Infant wide-field retinal image:
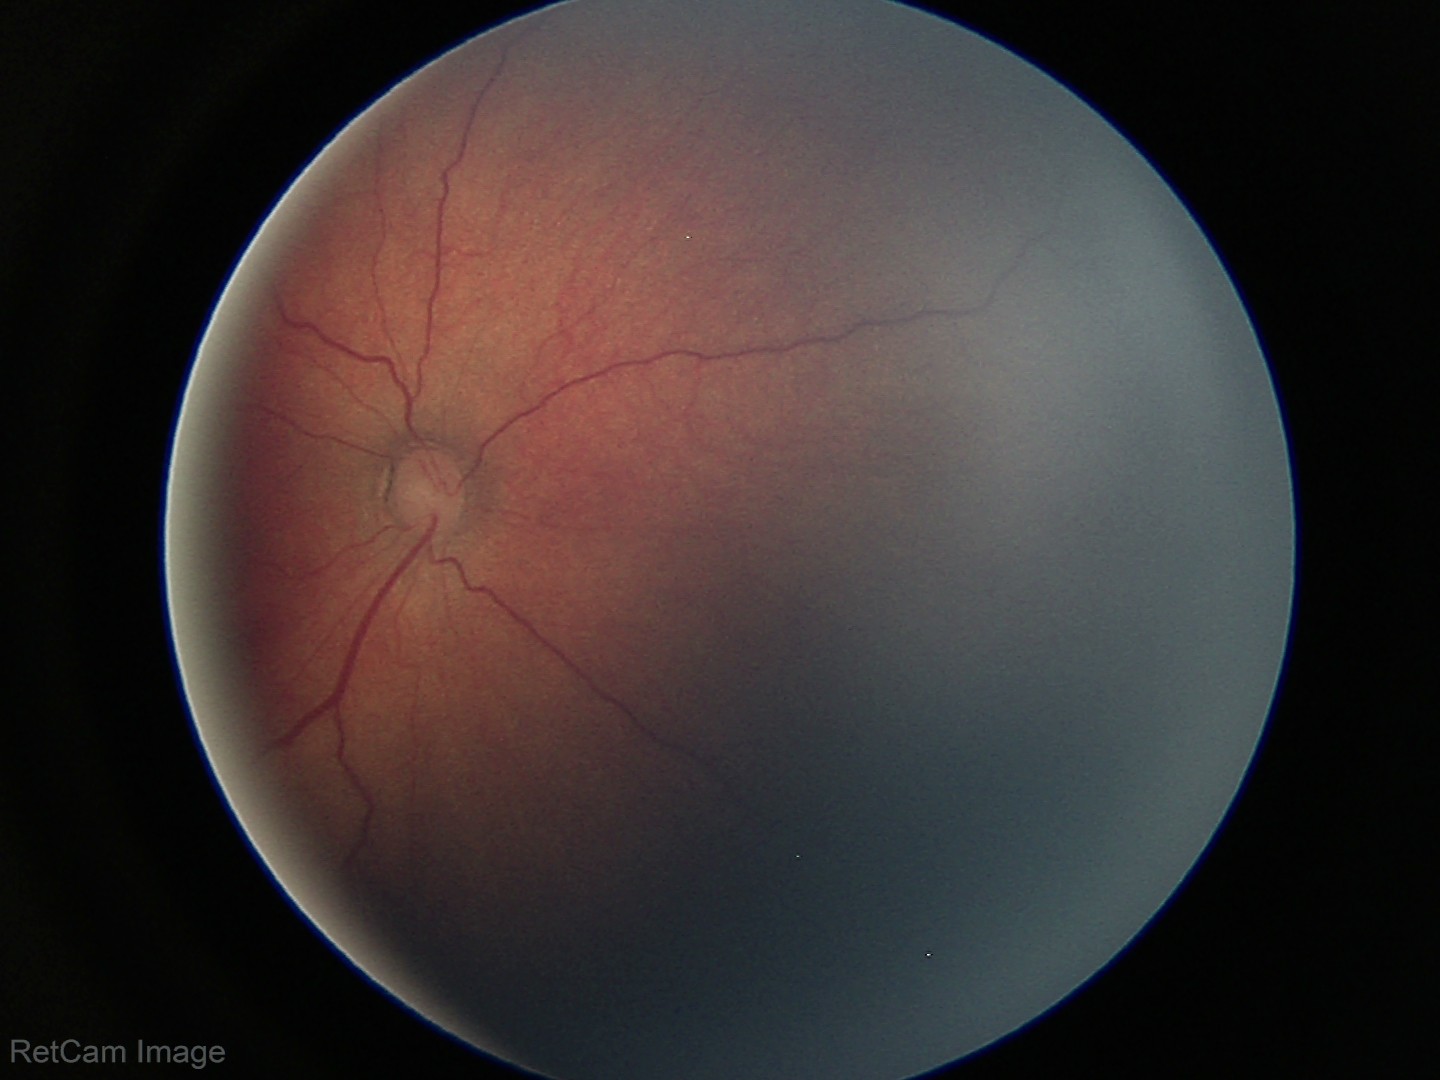

From an examination with diagnosis of ROP stage 3.